Pediatric wide-field fundus photograph · 1240x1240px.
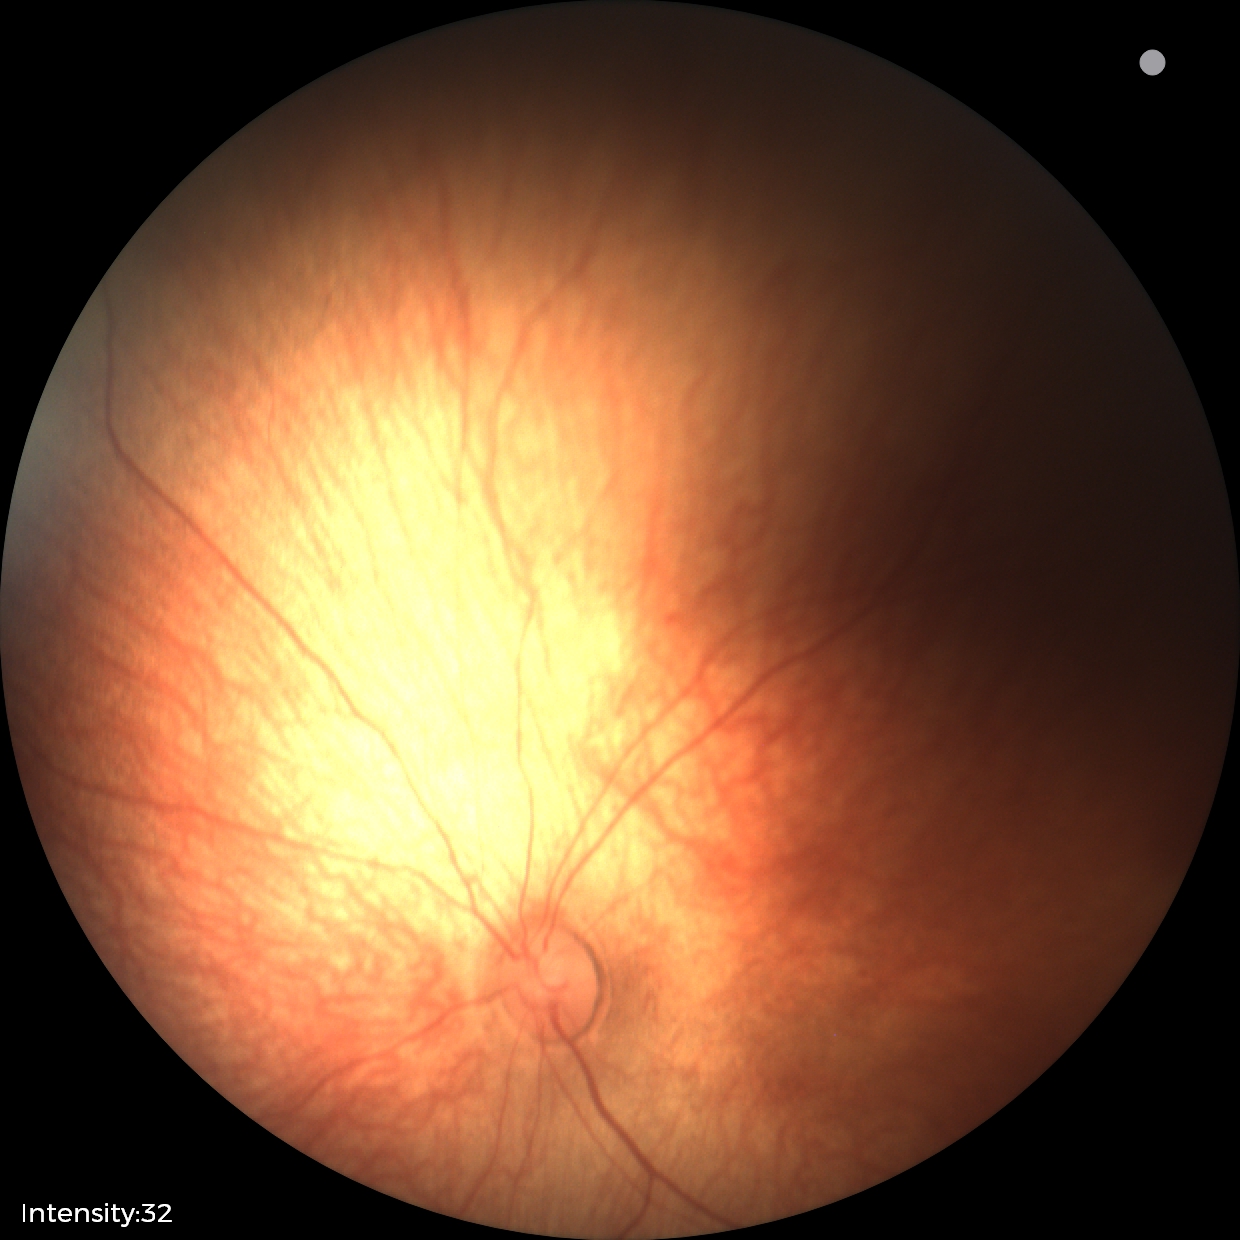

Screening diagnosis: physiological finding.